Centered on the optic disc · color fundus photograph:
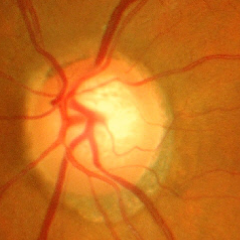

Q: Does this eye have glaucoma?
A: Yes — advanced glaucoma.